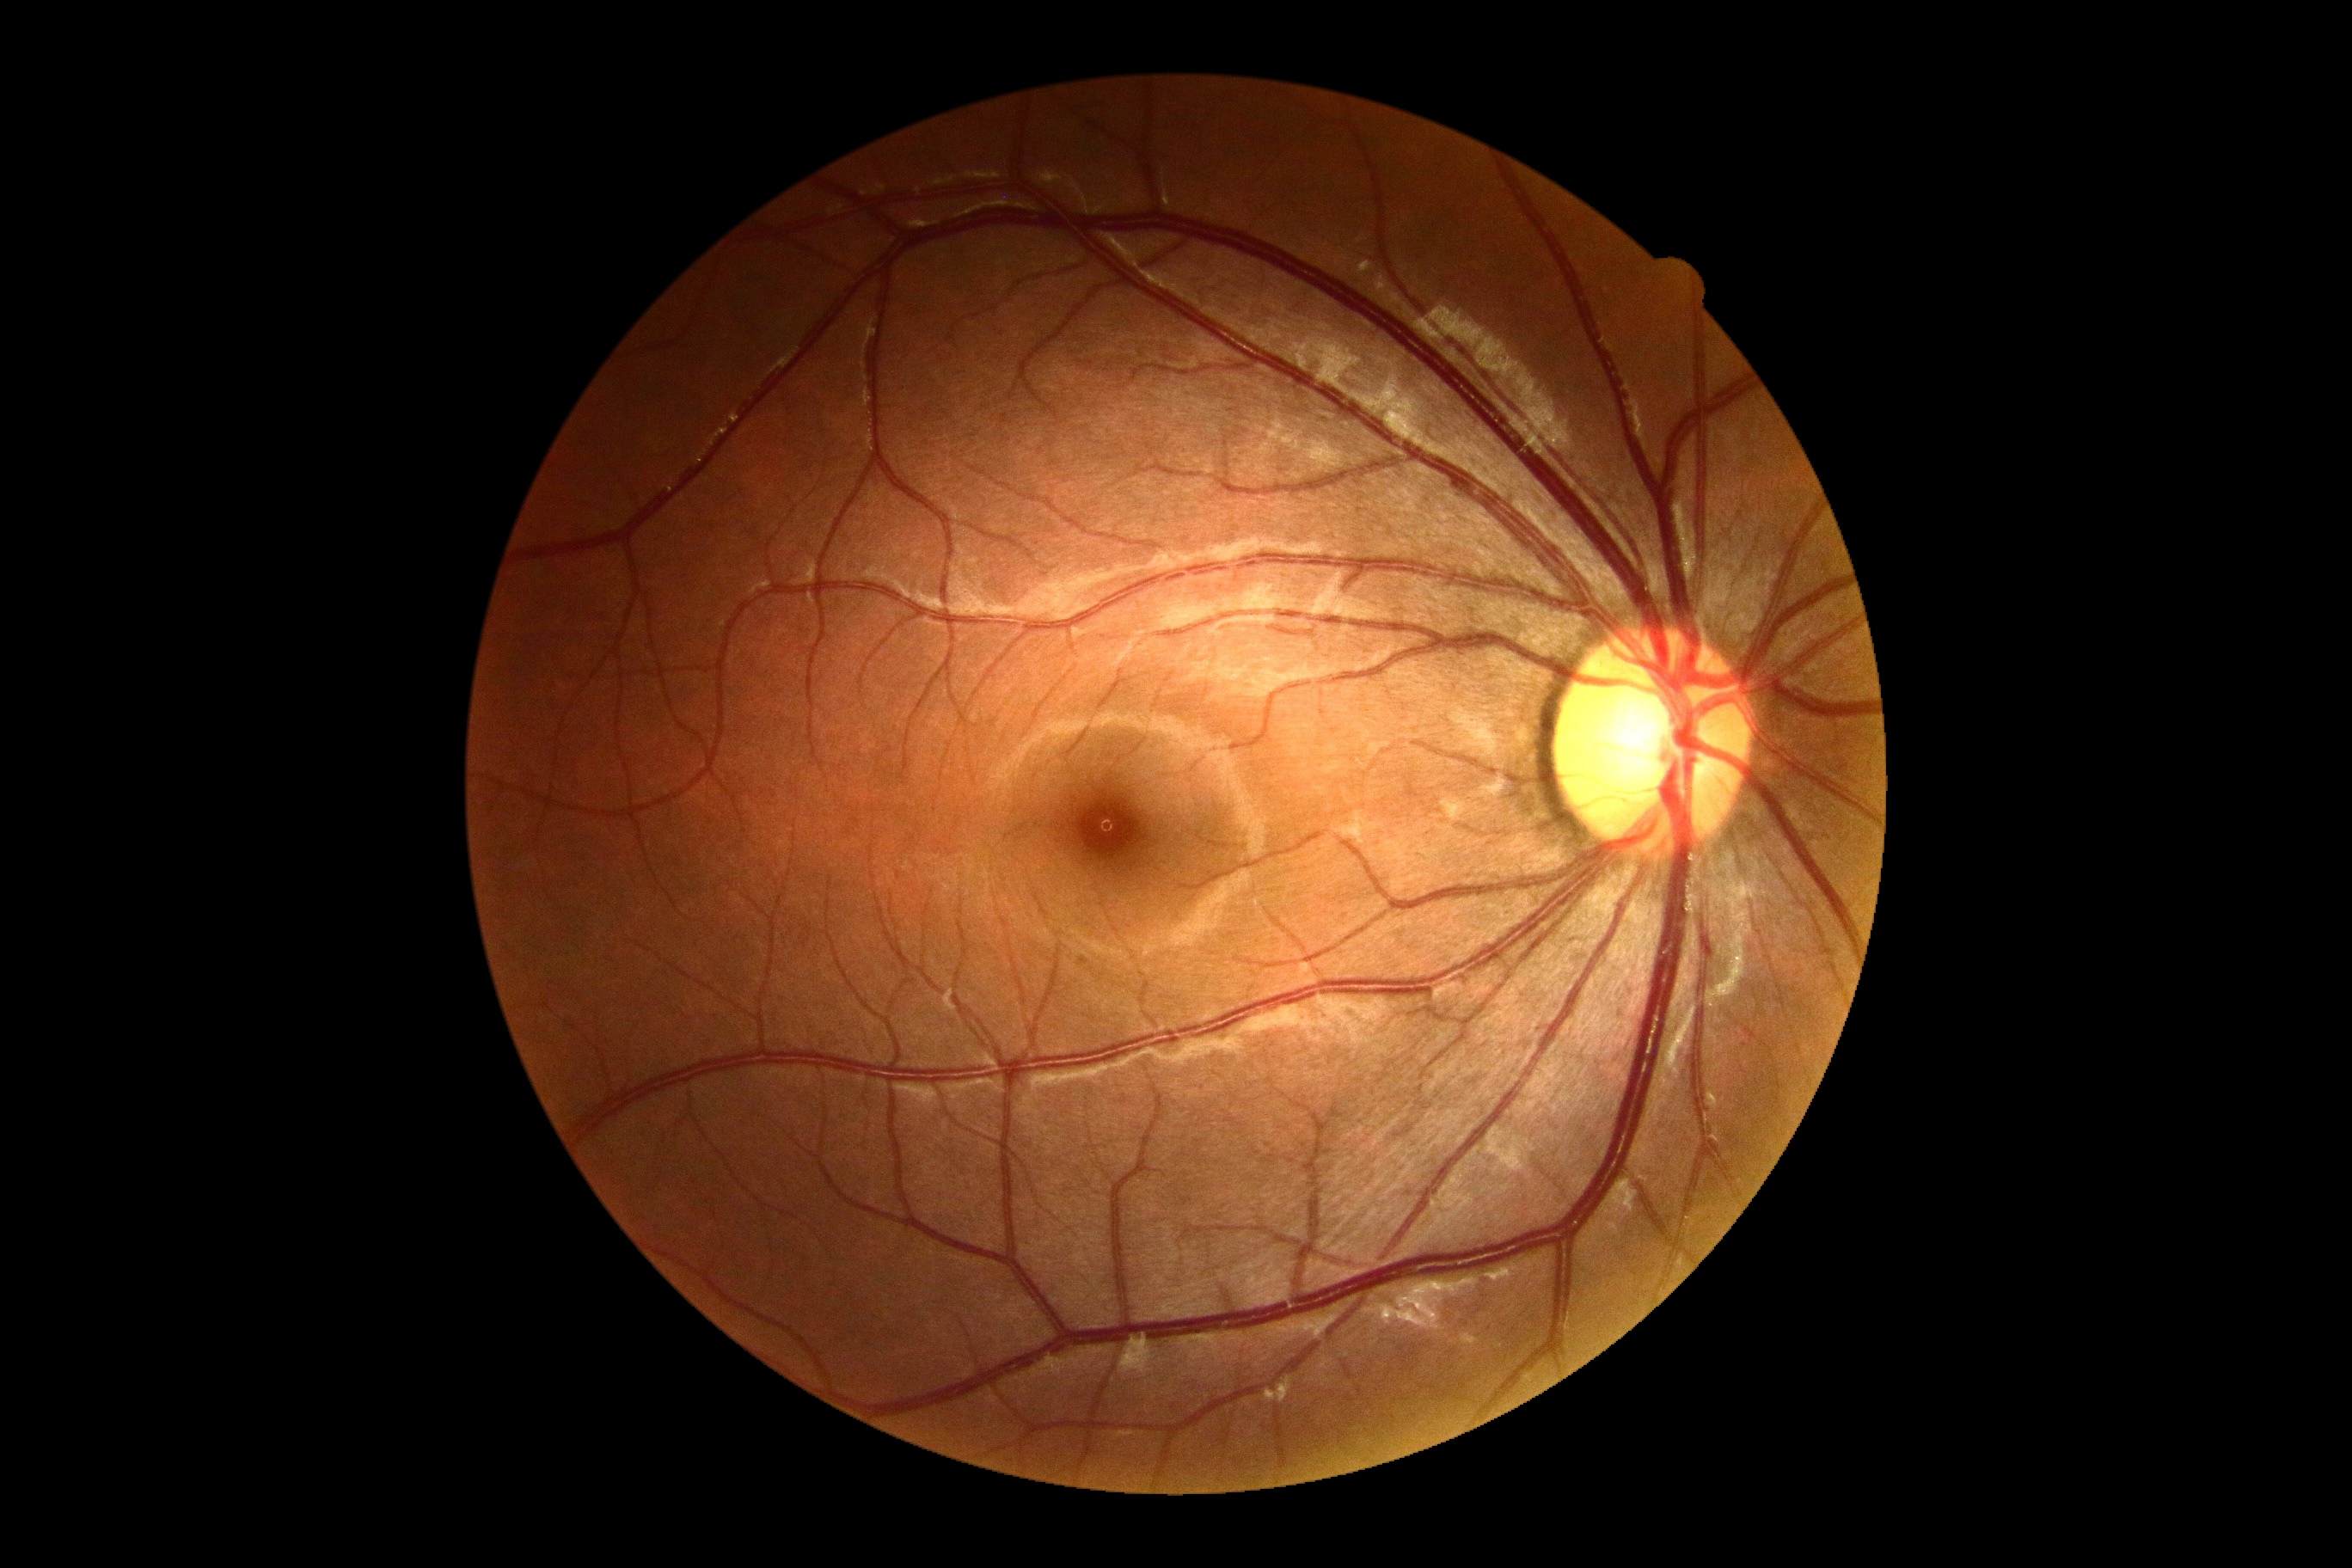 DR grade: no apparent retinopathy (0).